FOV: 45 degrees, color fundus image.
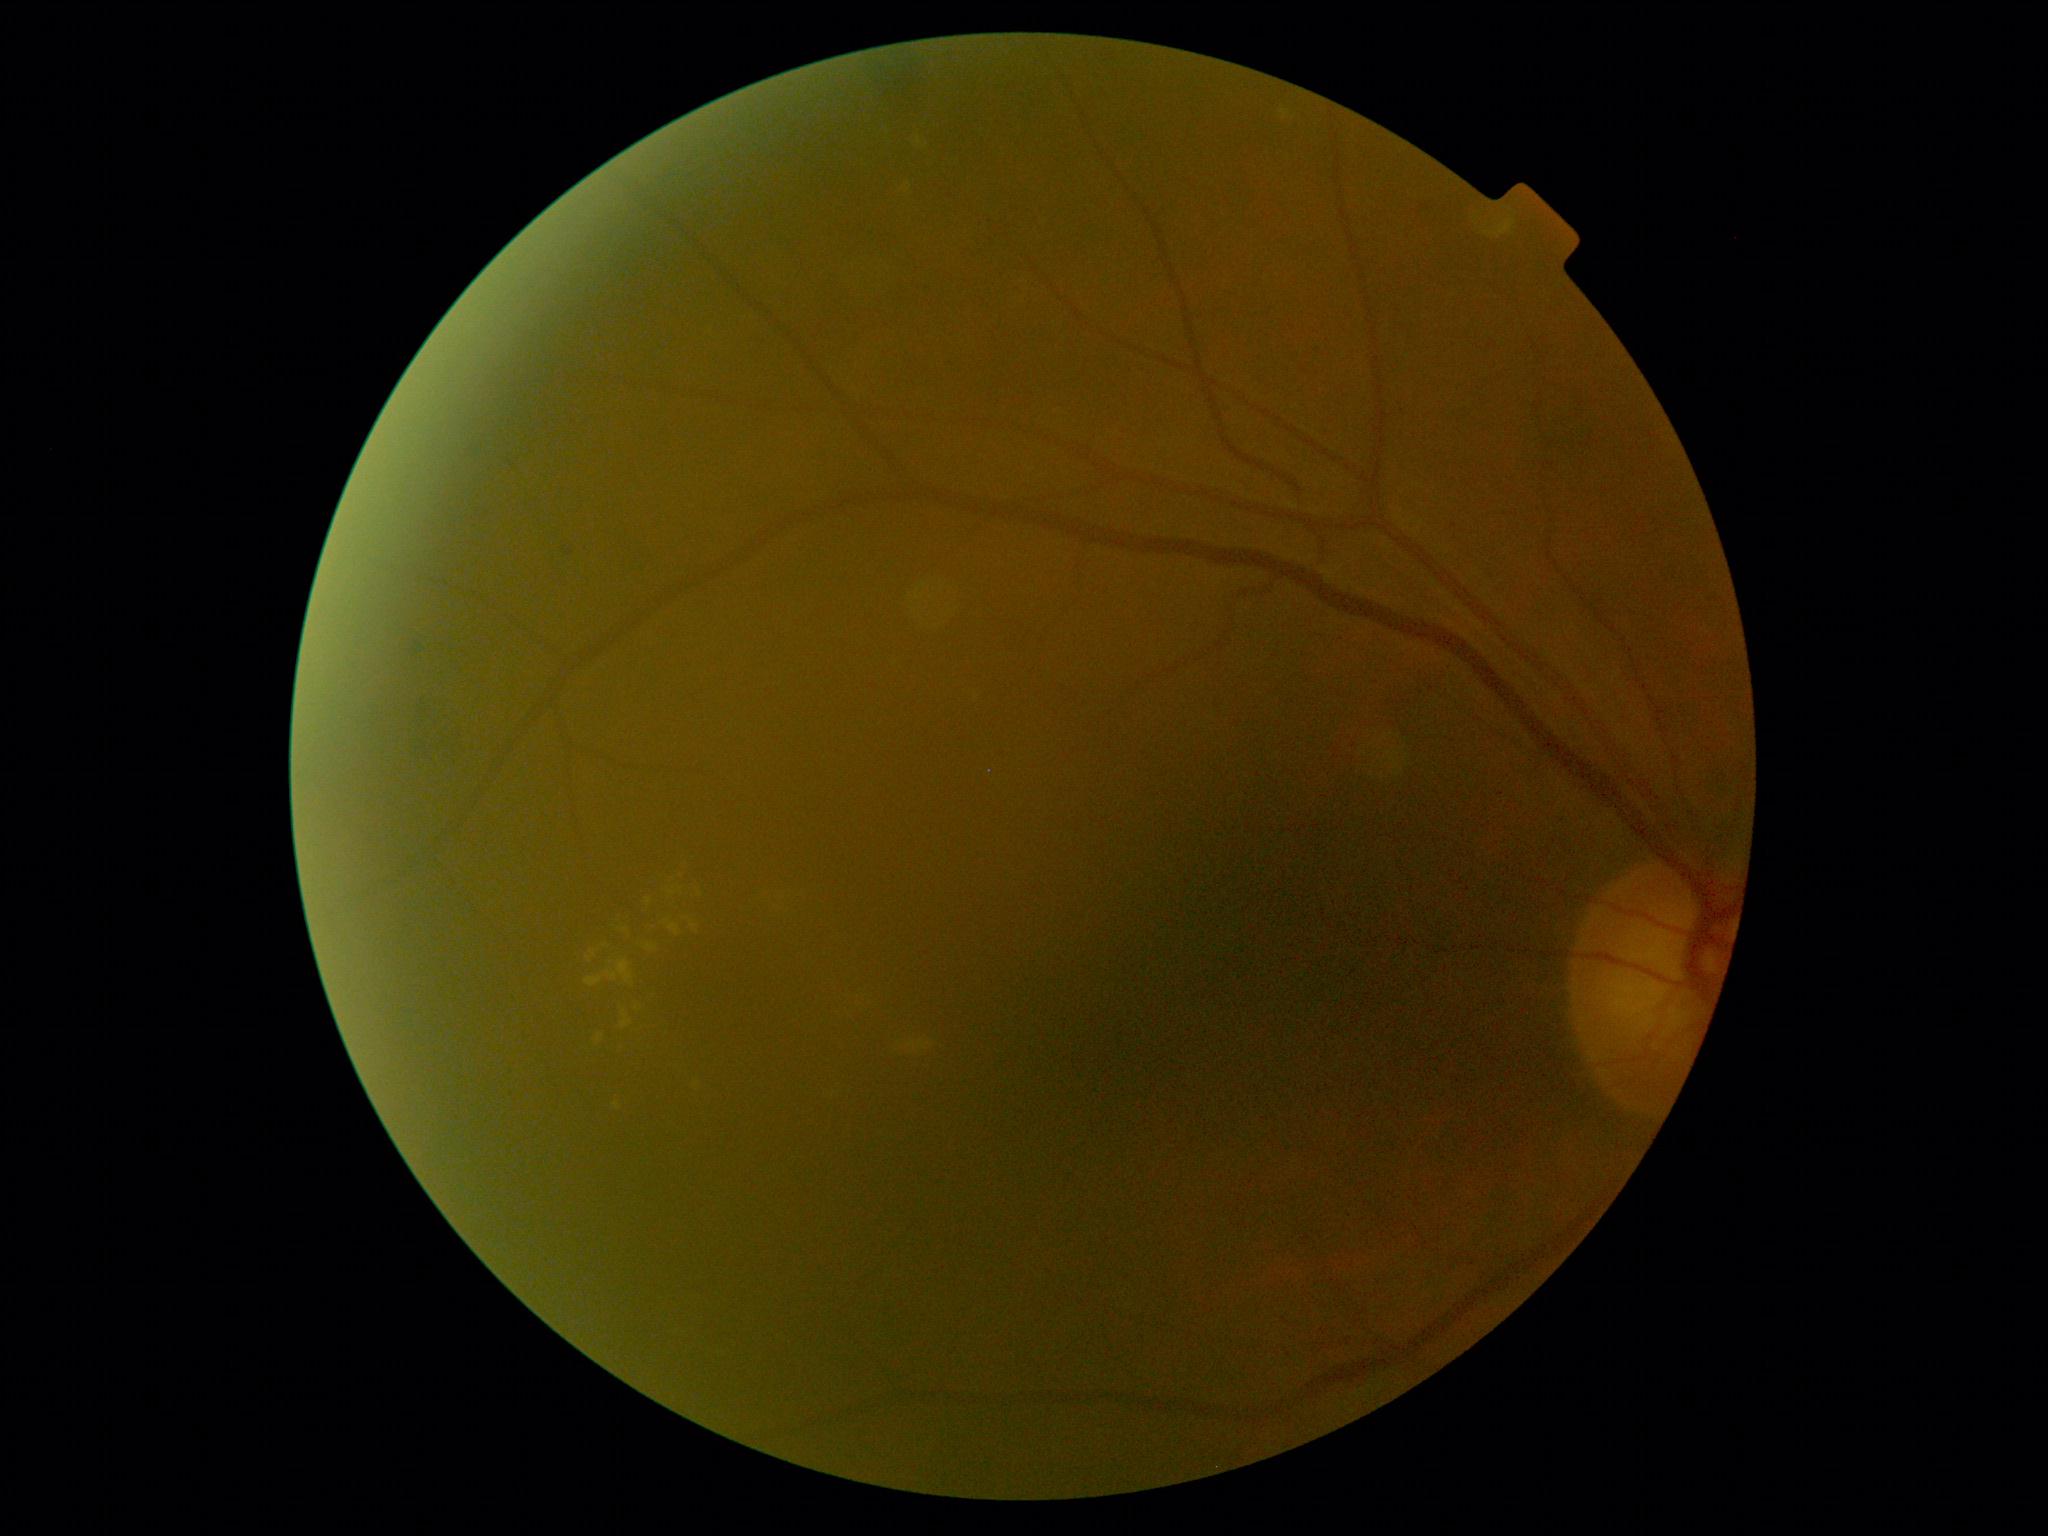
DR class: non-proliferative diabetic retinopathy. Diabetic retinopathy (DR): moderate NPDR (grade 2).